Wide-field fundus photograph of an infant: 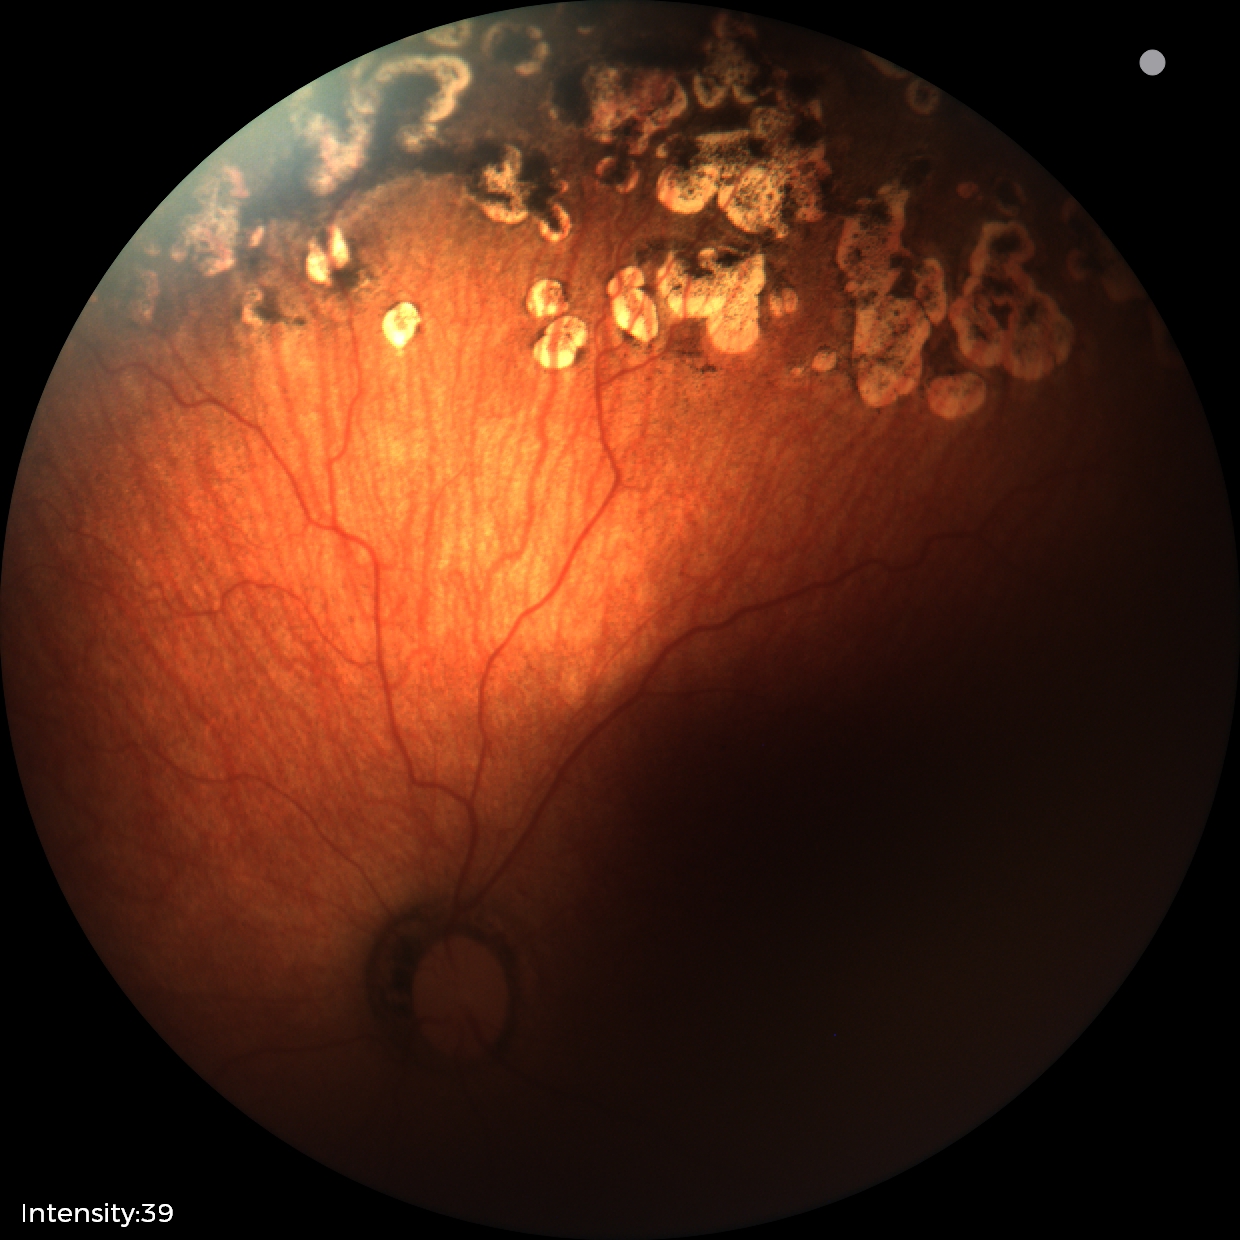 Diagnosis from this screening exam: status post retinopathy of prematurity.